45° field of view · color fundus image:
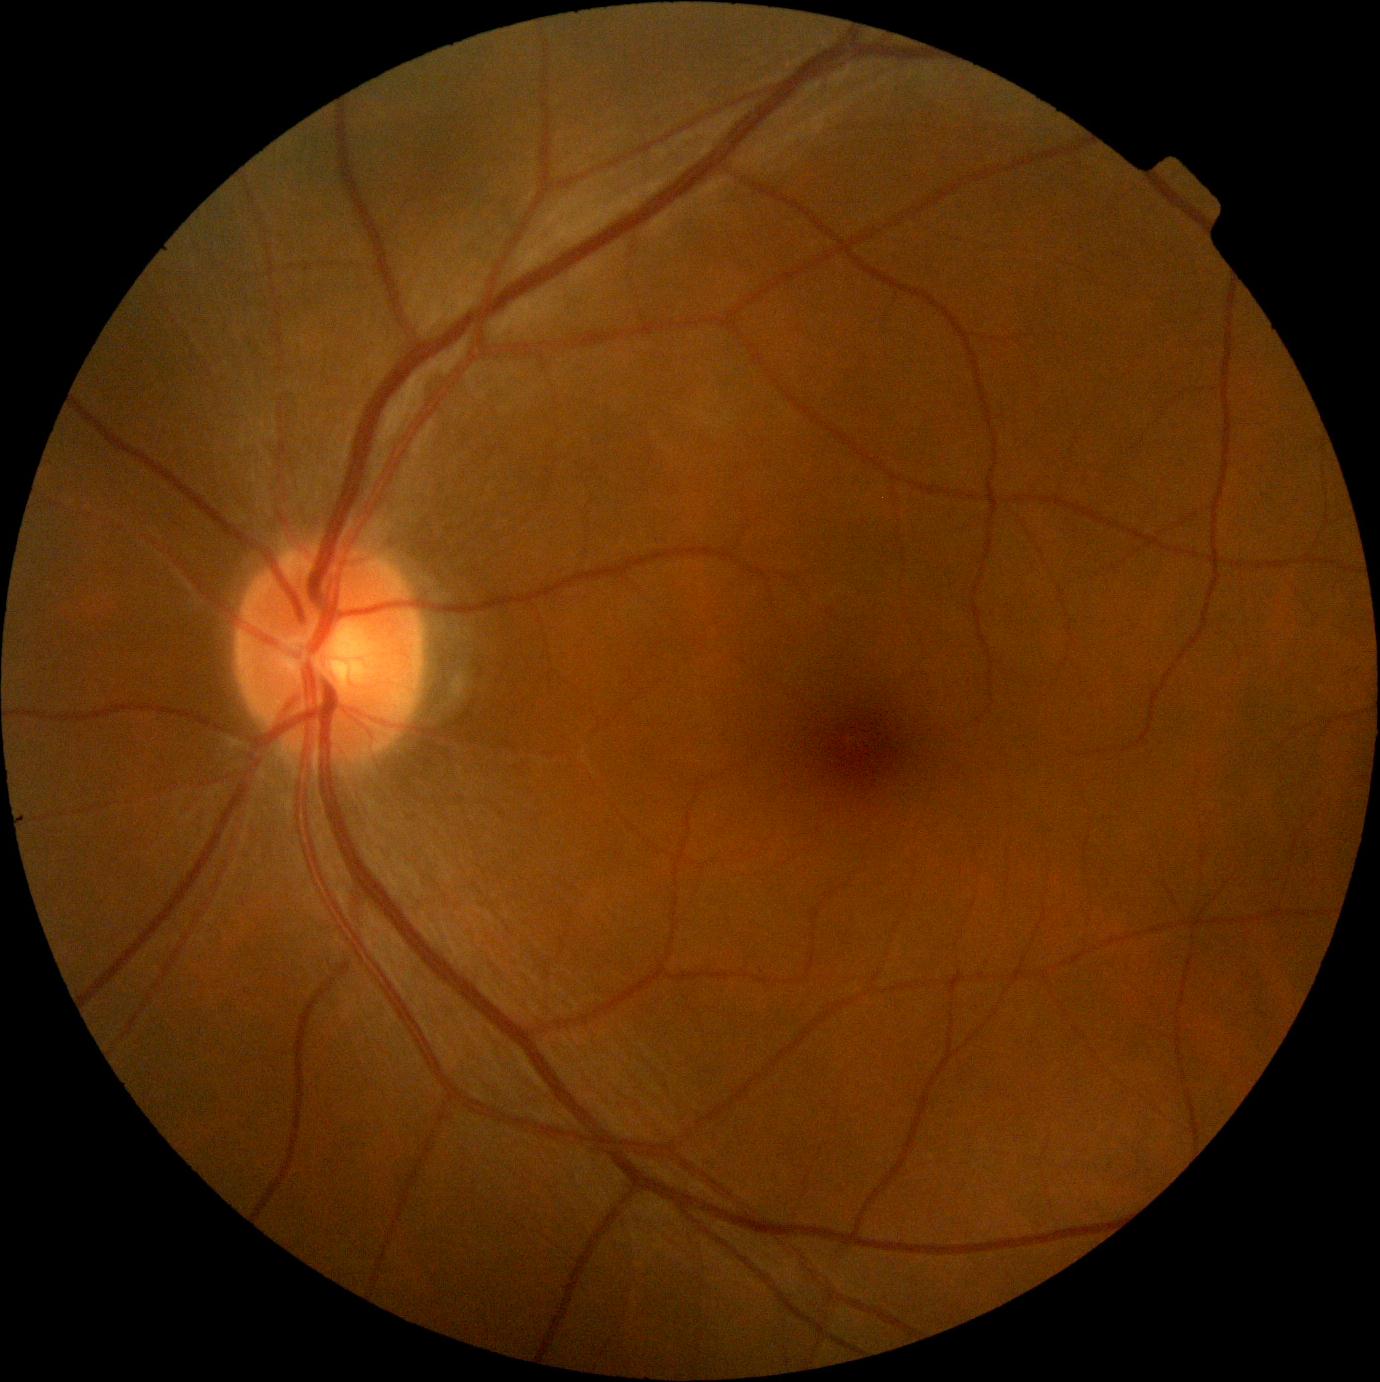

– DR grade — 0